1932x1910px.
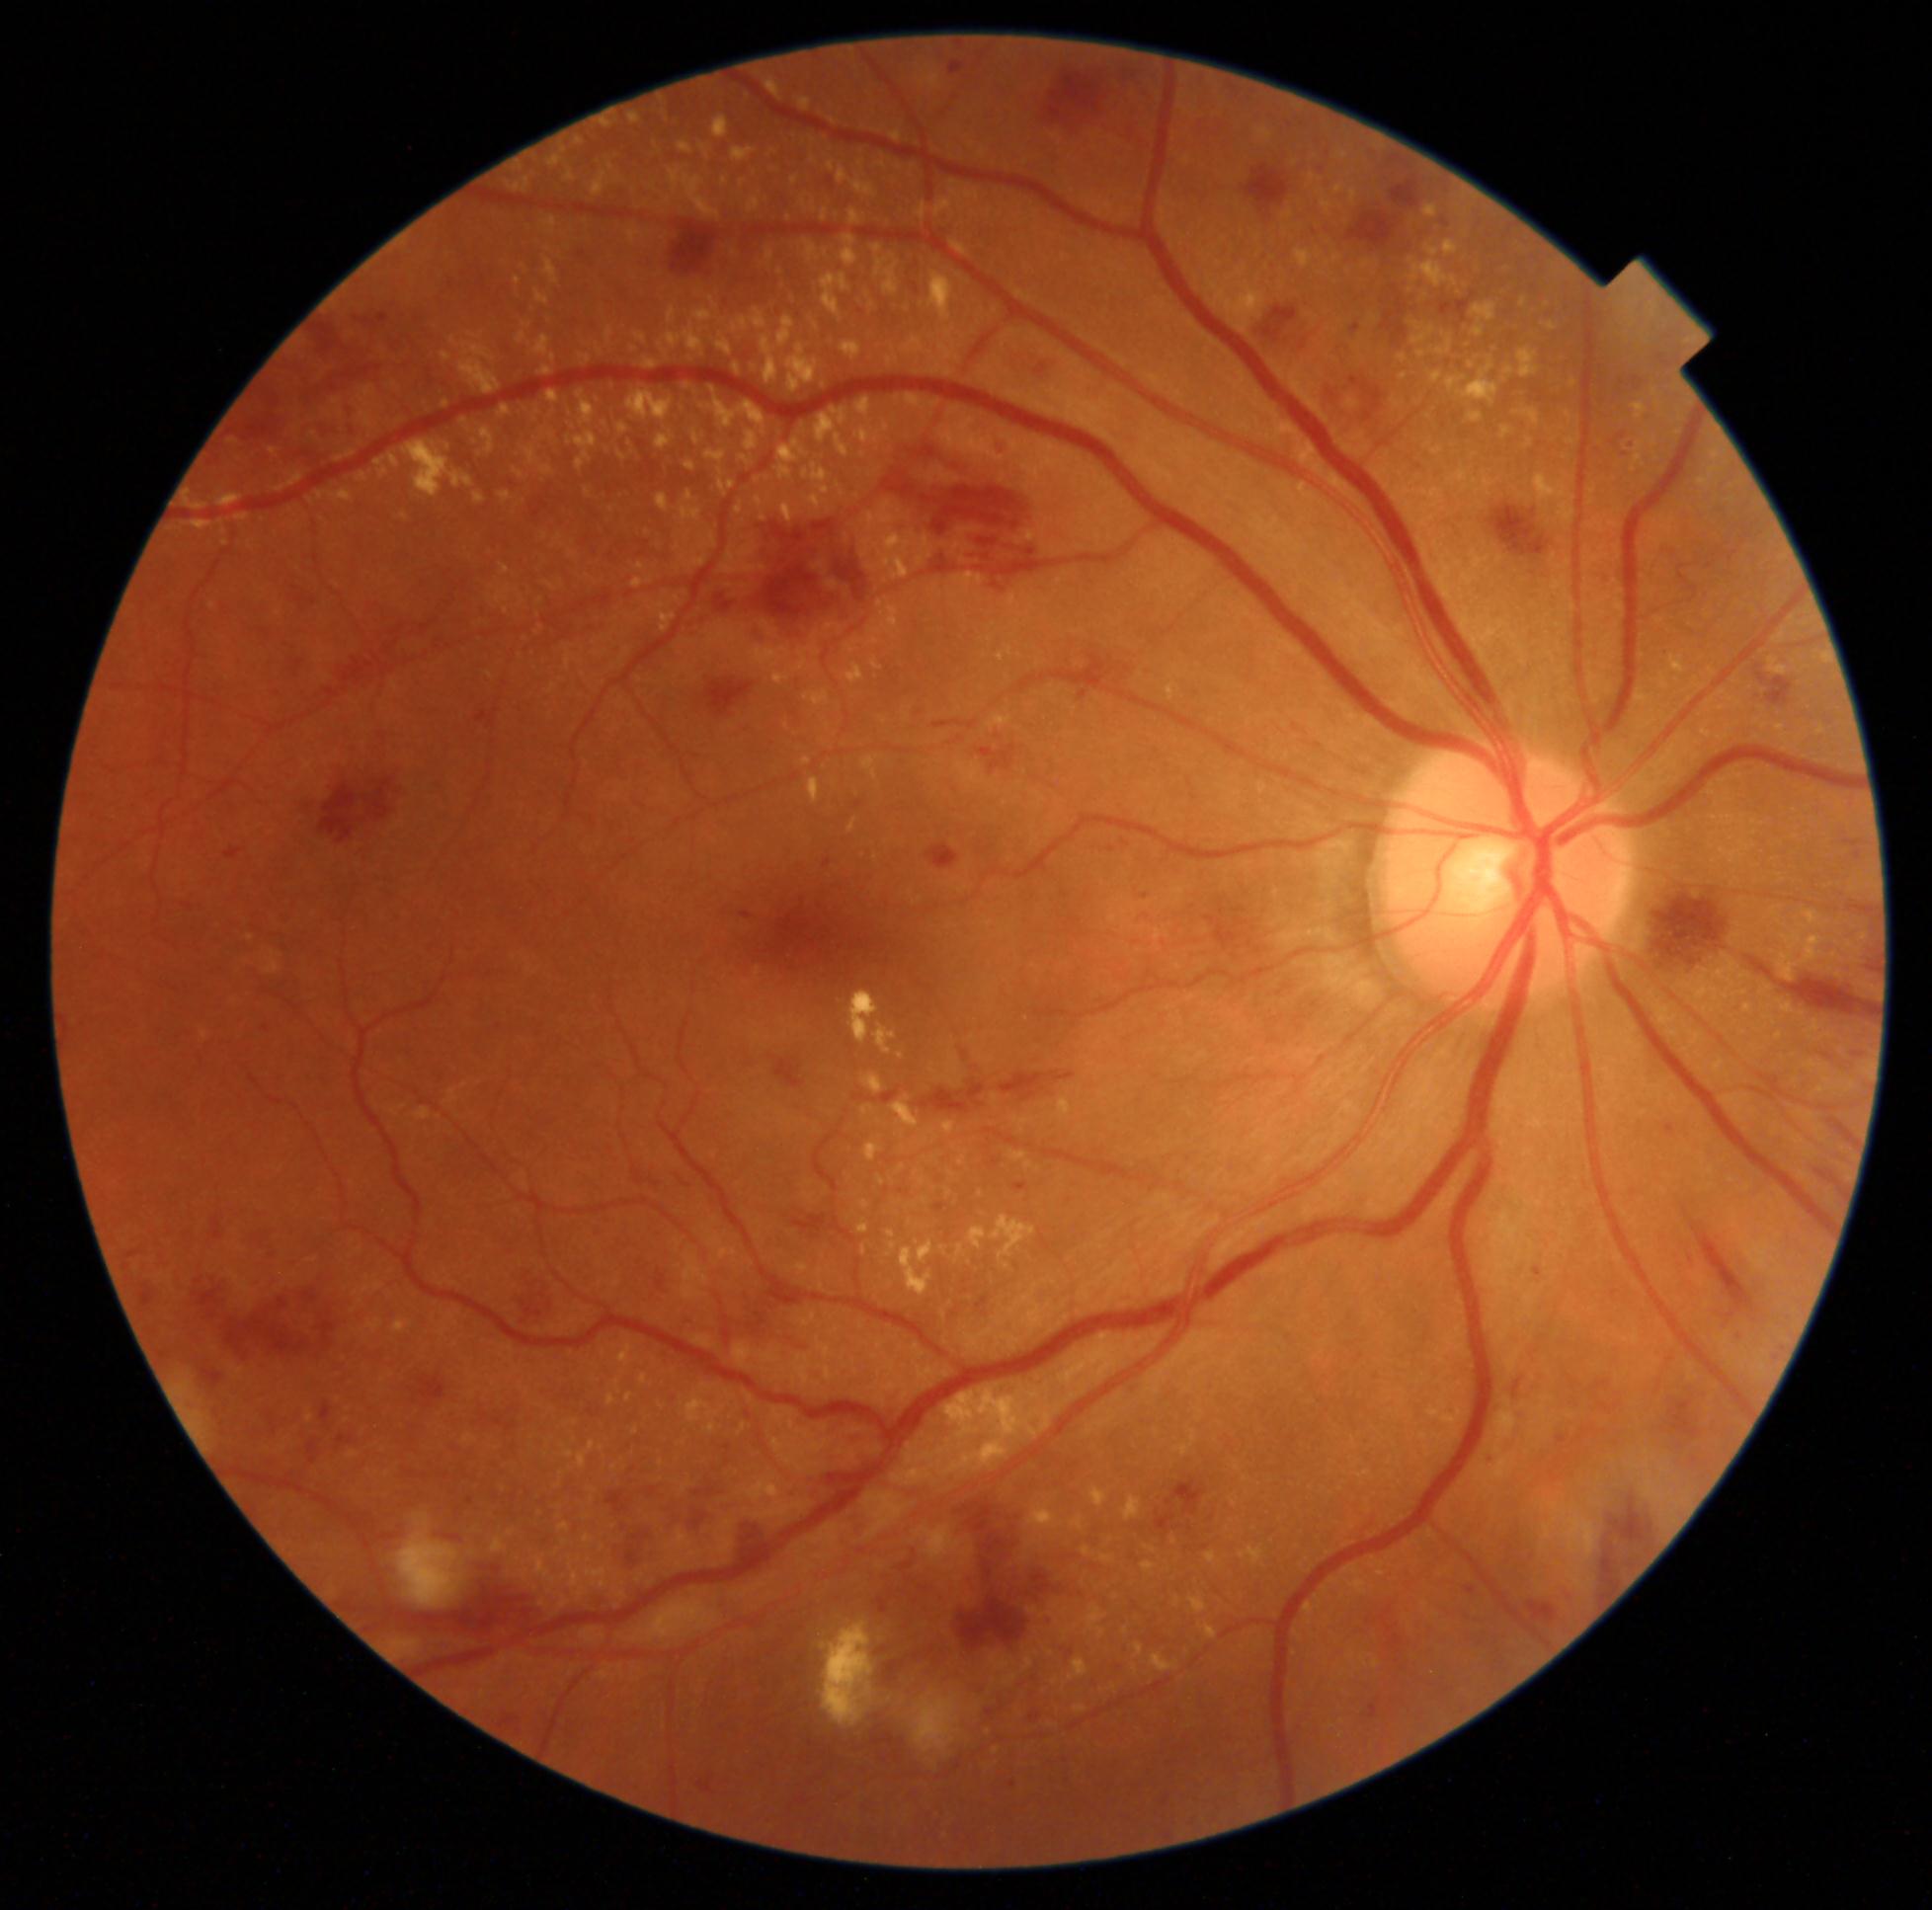 {"dr_category": "non-proliferative diabetic retinopathy", "dr_grade": "severe non-proliferative diabetic retinopathy (grade 3)"}